Pediatric wide-field fundus photograph: 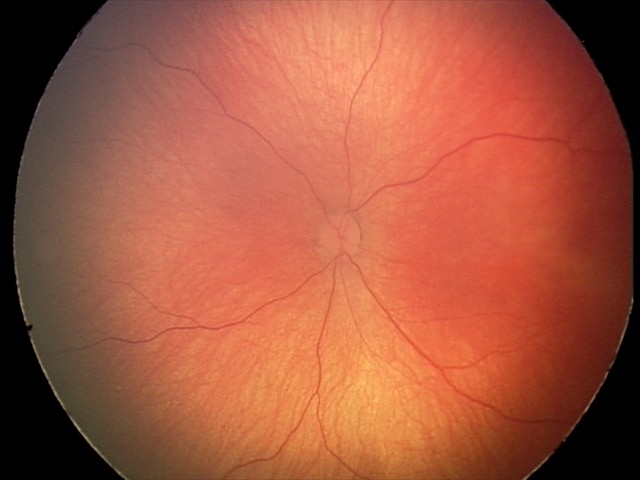 Examination diagnosed as retinal hemorrhages.